640x480 · RetCam wide-field infant fundus image
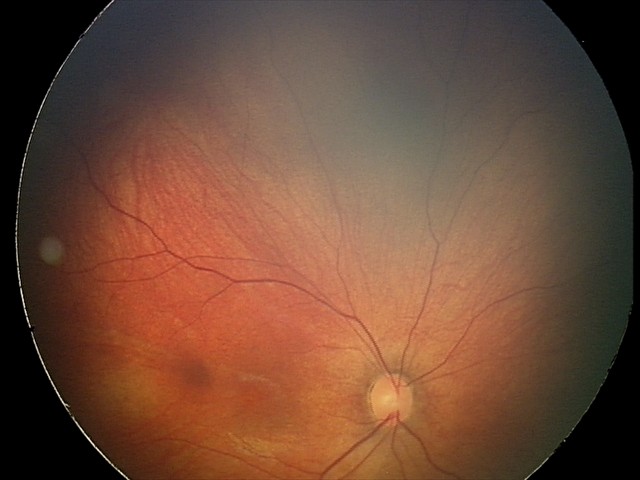
Diagnosis from this screening exam: retinal hemorrhages.